Handheld portable fundus camera image:
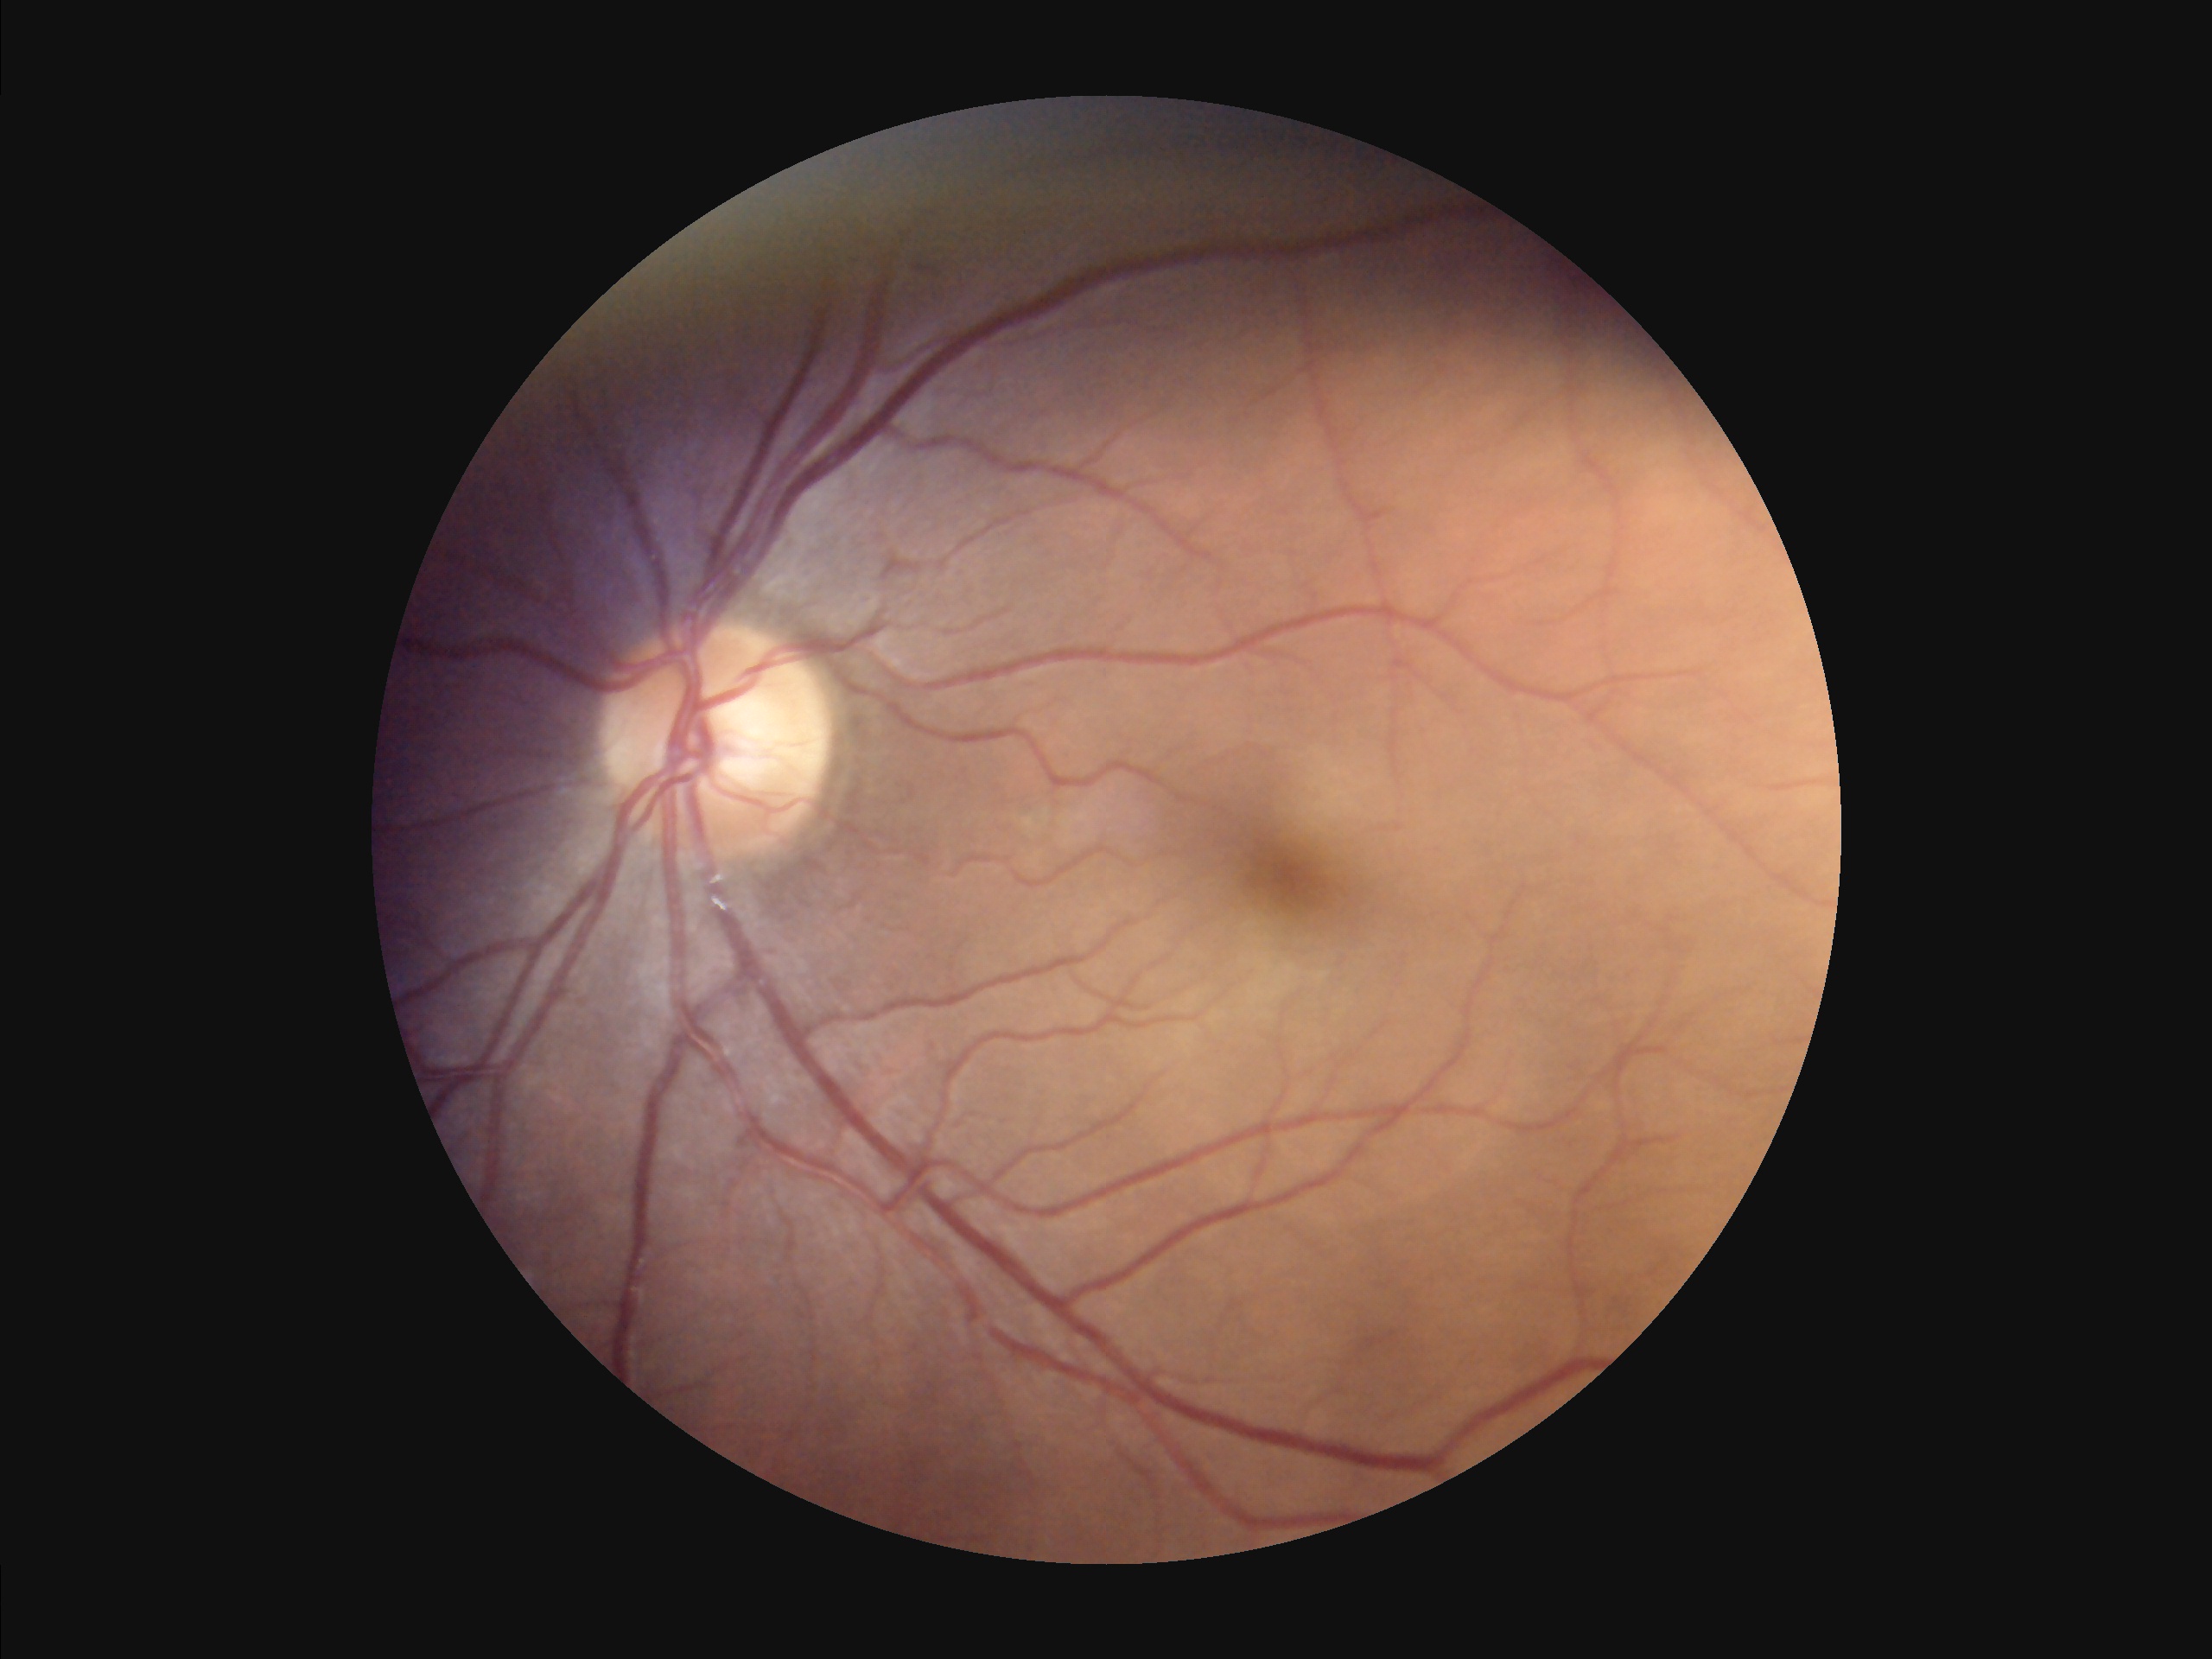

{"illumination": "good illumination and color balance", "contrast": "wide intensity range, structures distinguishable"}